Forus 3Nethra fundus camera · fundus photo:
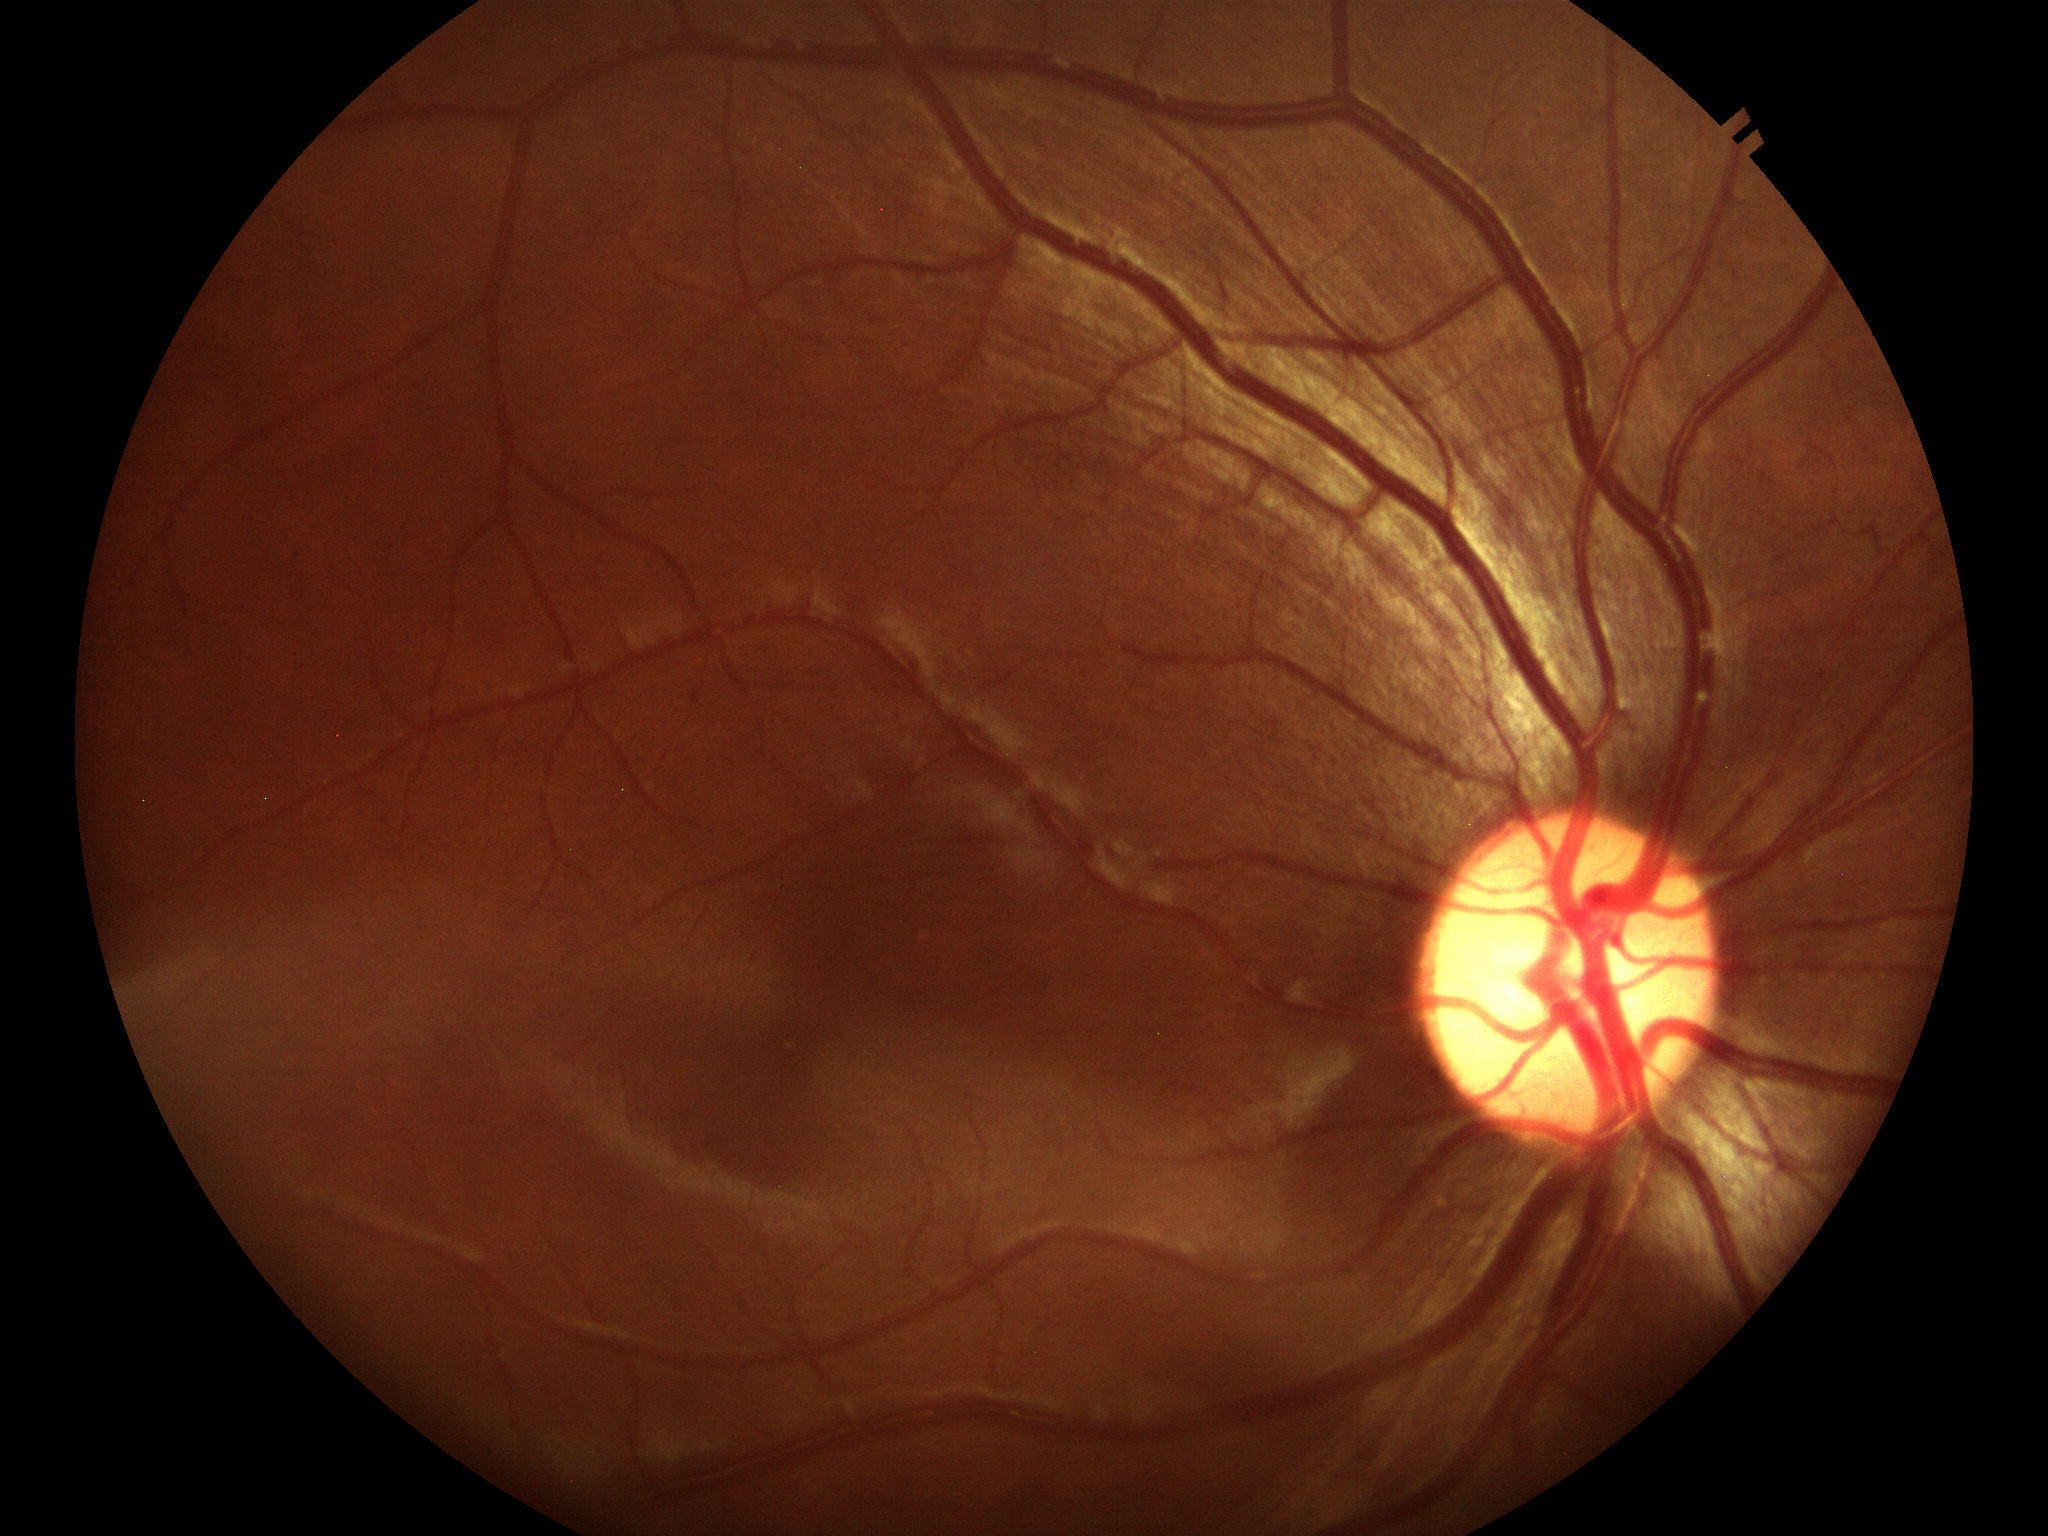 Annotations:
* horizontal cup-to-disc ratio — 0.58
* Glaucoma screening — negative
* vertical cup-to-disc ratio — 0.57